CFP:
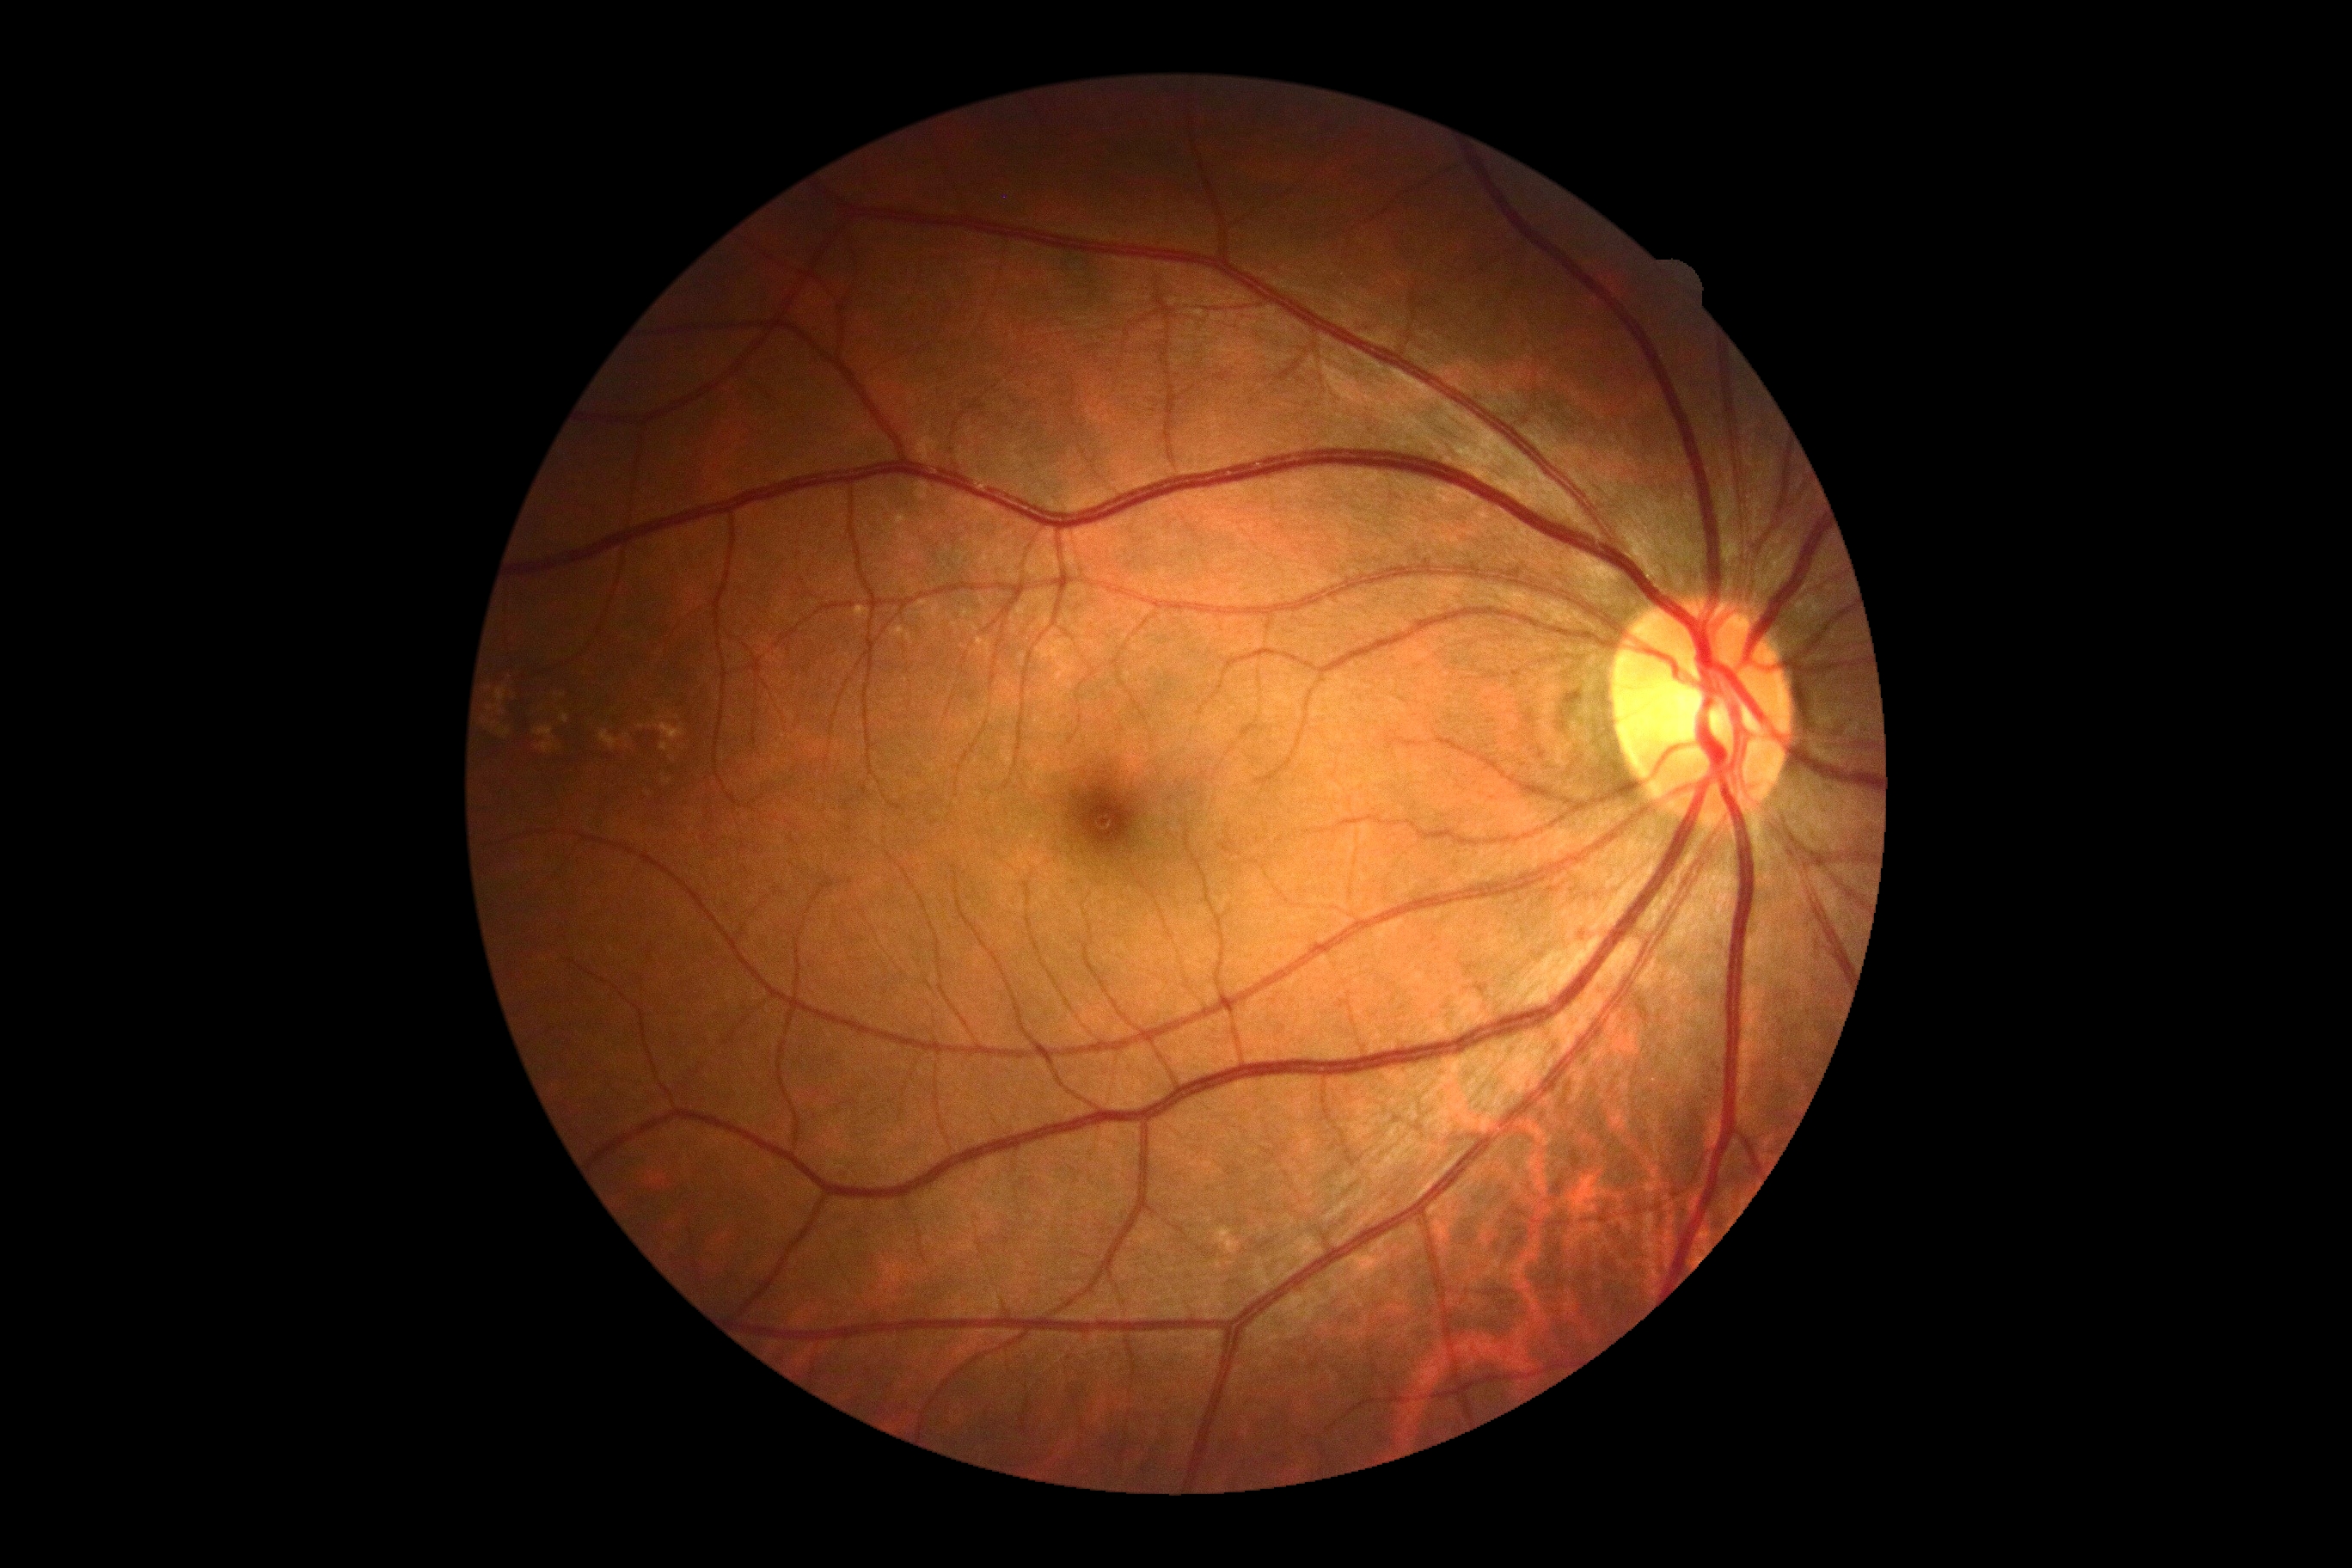

DR severity: 0.